45° FOV, CFP
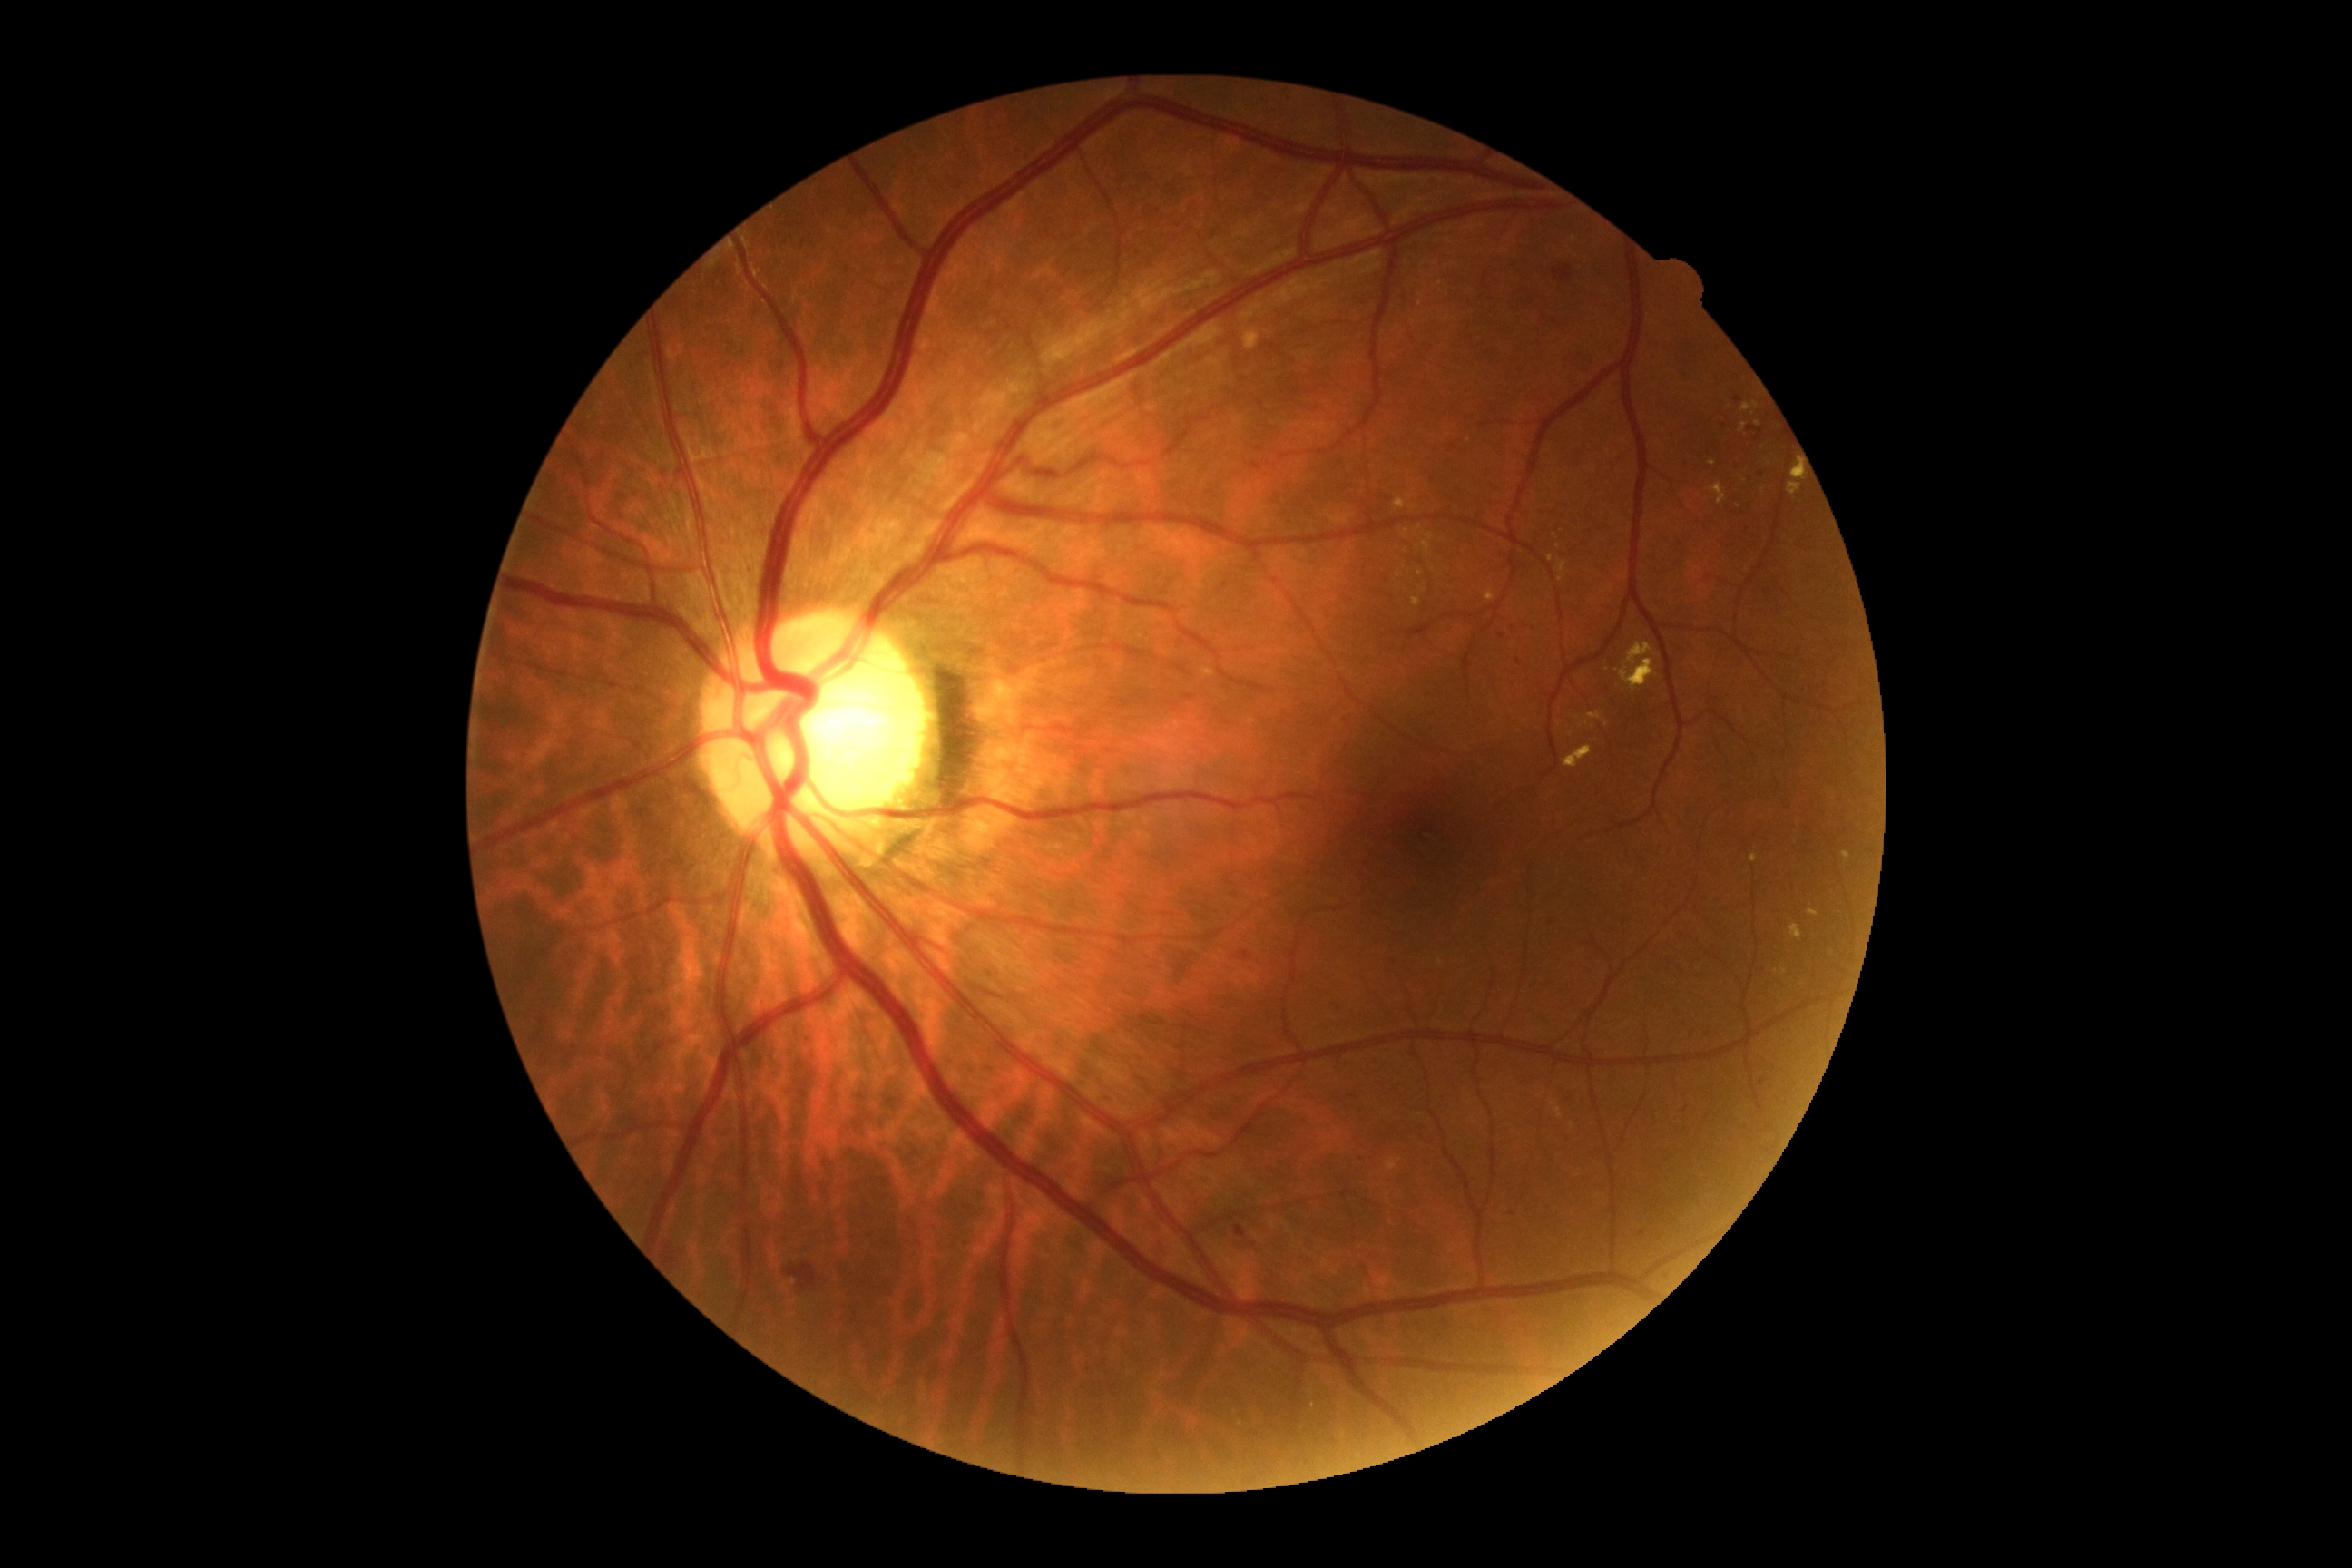   dr_grade: grade 2 (moderate NPDR)